NIDEK AFC-230; nonmydriatic; 45° FOV; color fundus image; 848 x 848 pixels.
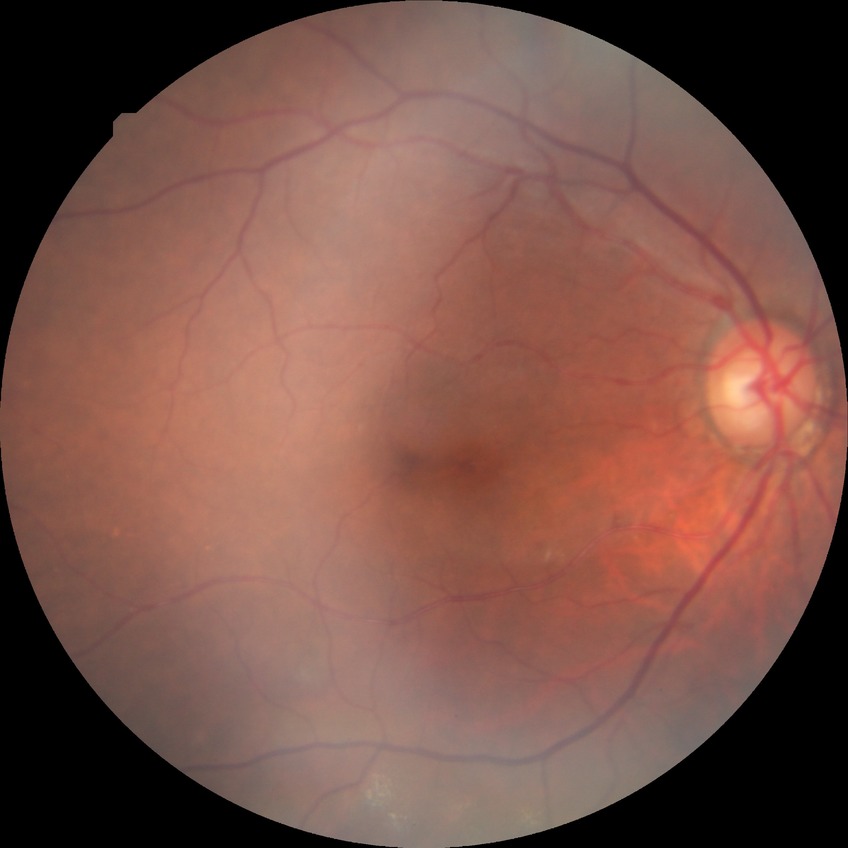
diabetic retinopathy severity: no diabetic retinopathy.